Infant wide-field fundus photograph. 1240x1240px
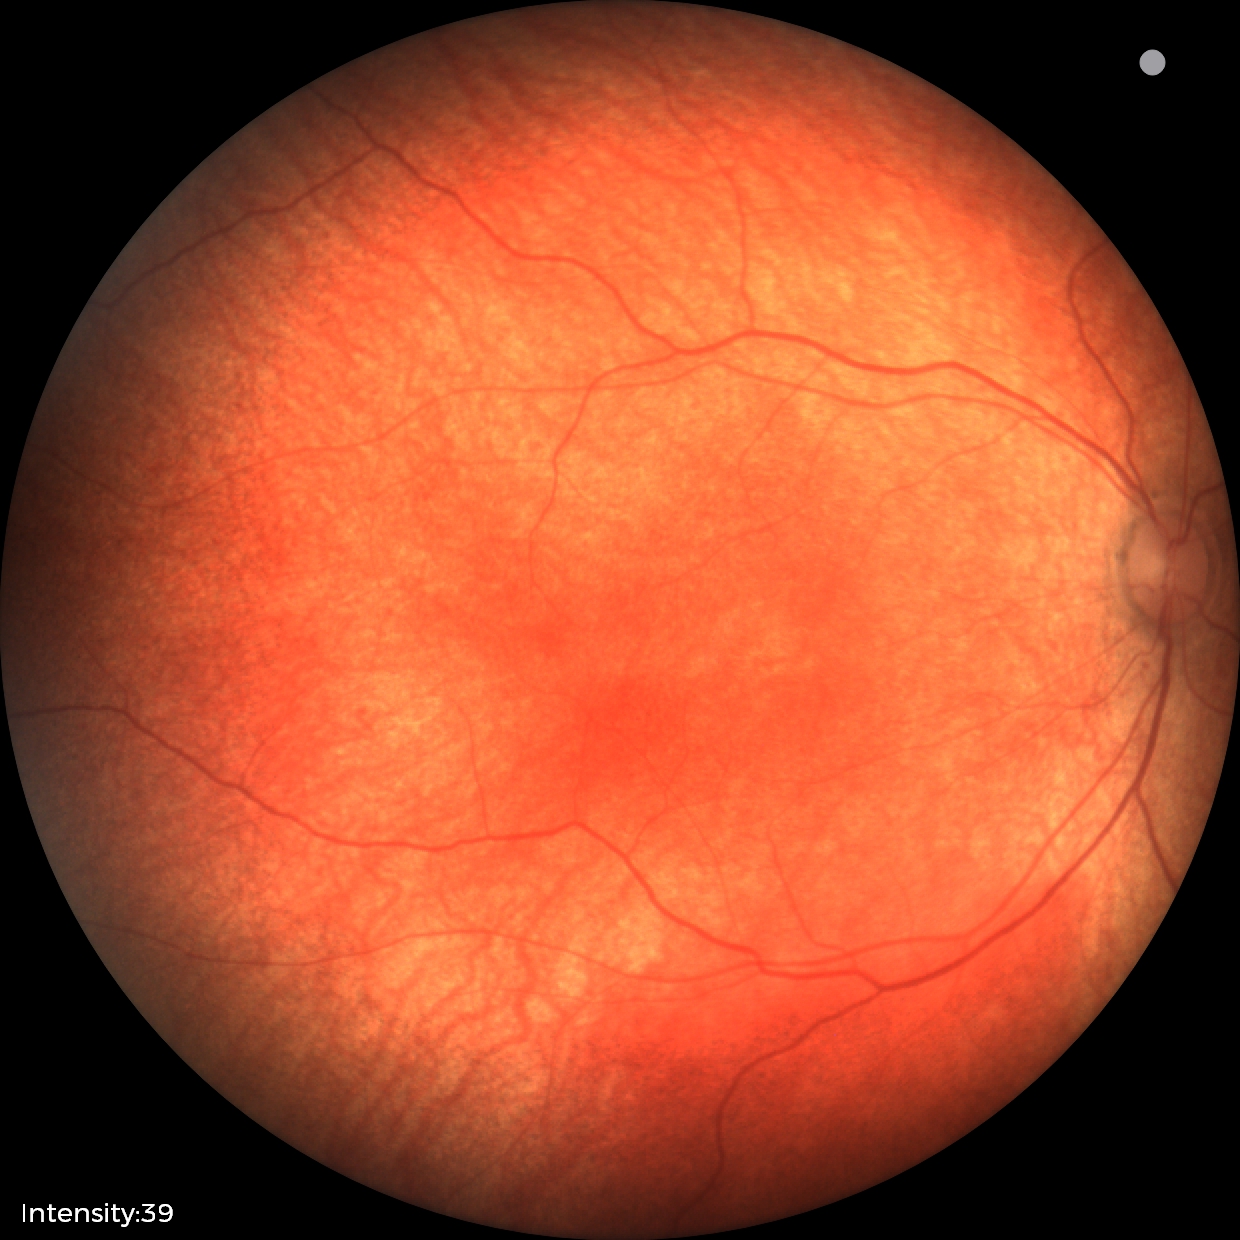

Examination with physiological retinal findings.